1932x1910px:
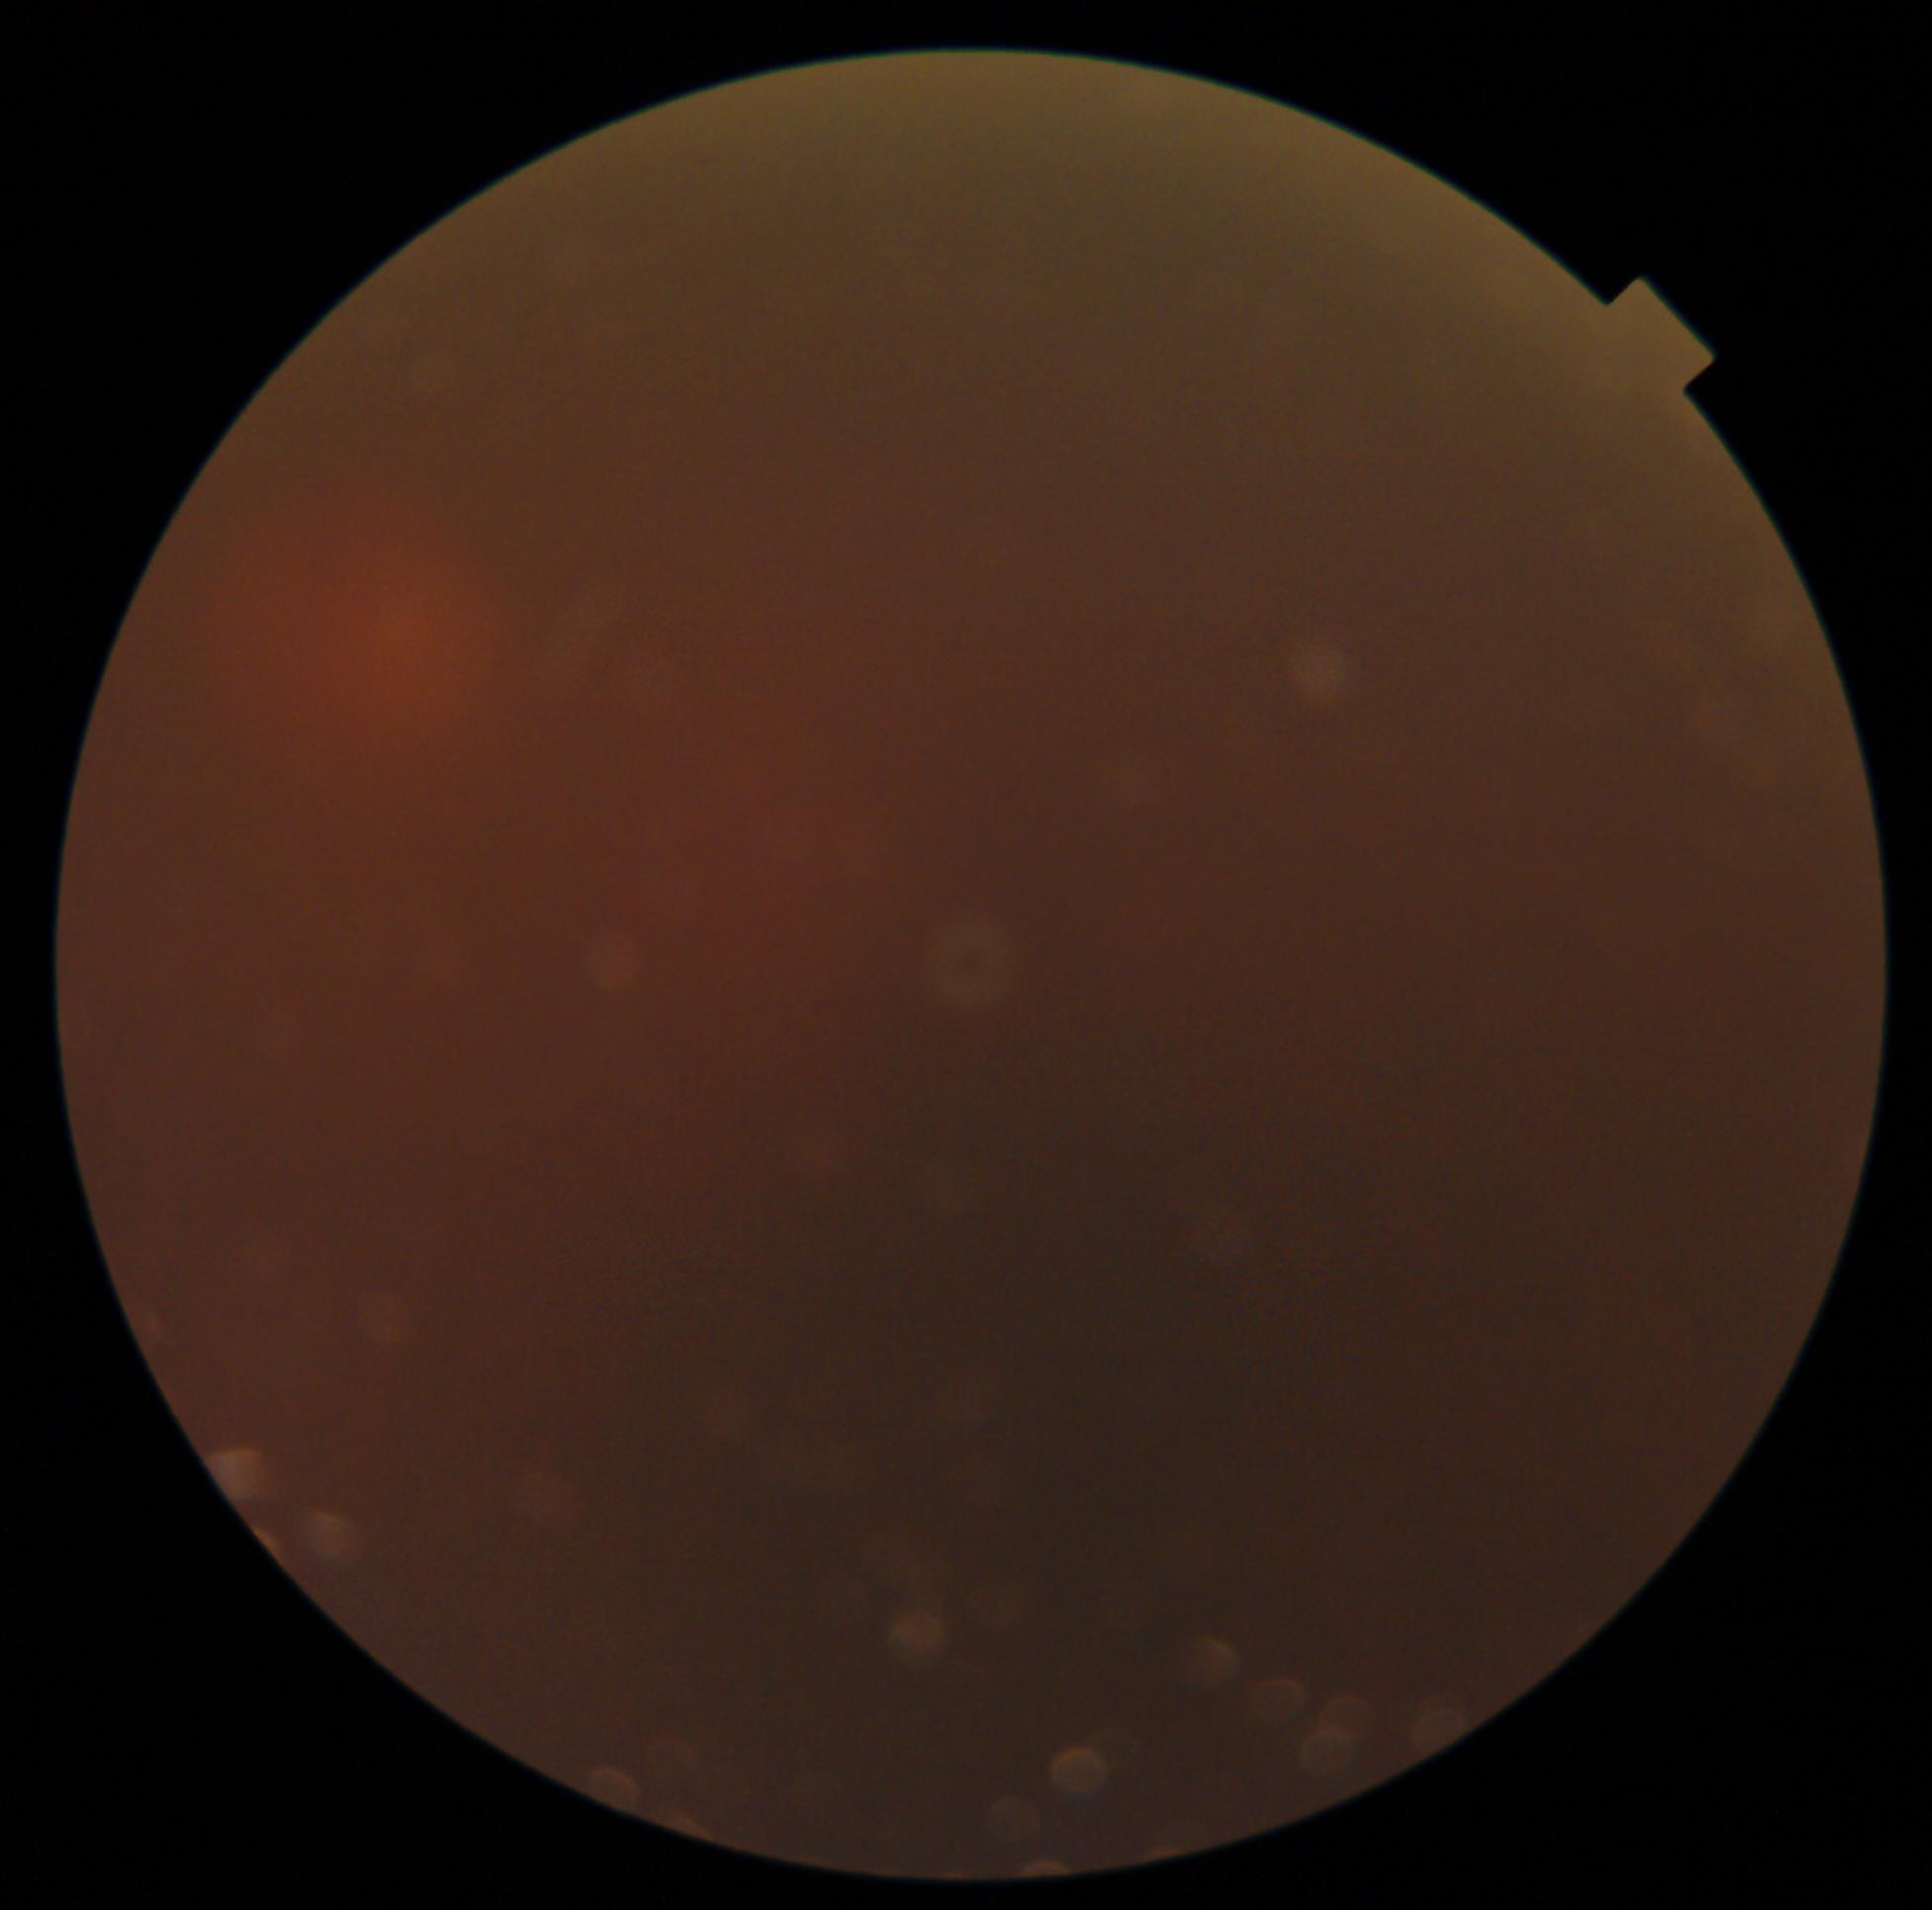

Diabetic retinopathy (DR) is ungradable due to poor image quality.